Color fundus photograph, 2352x1568px, 45-degree field of view.
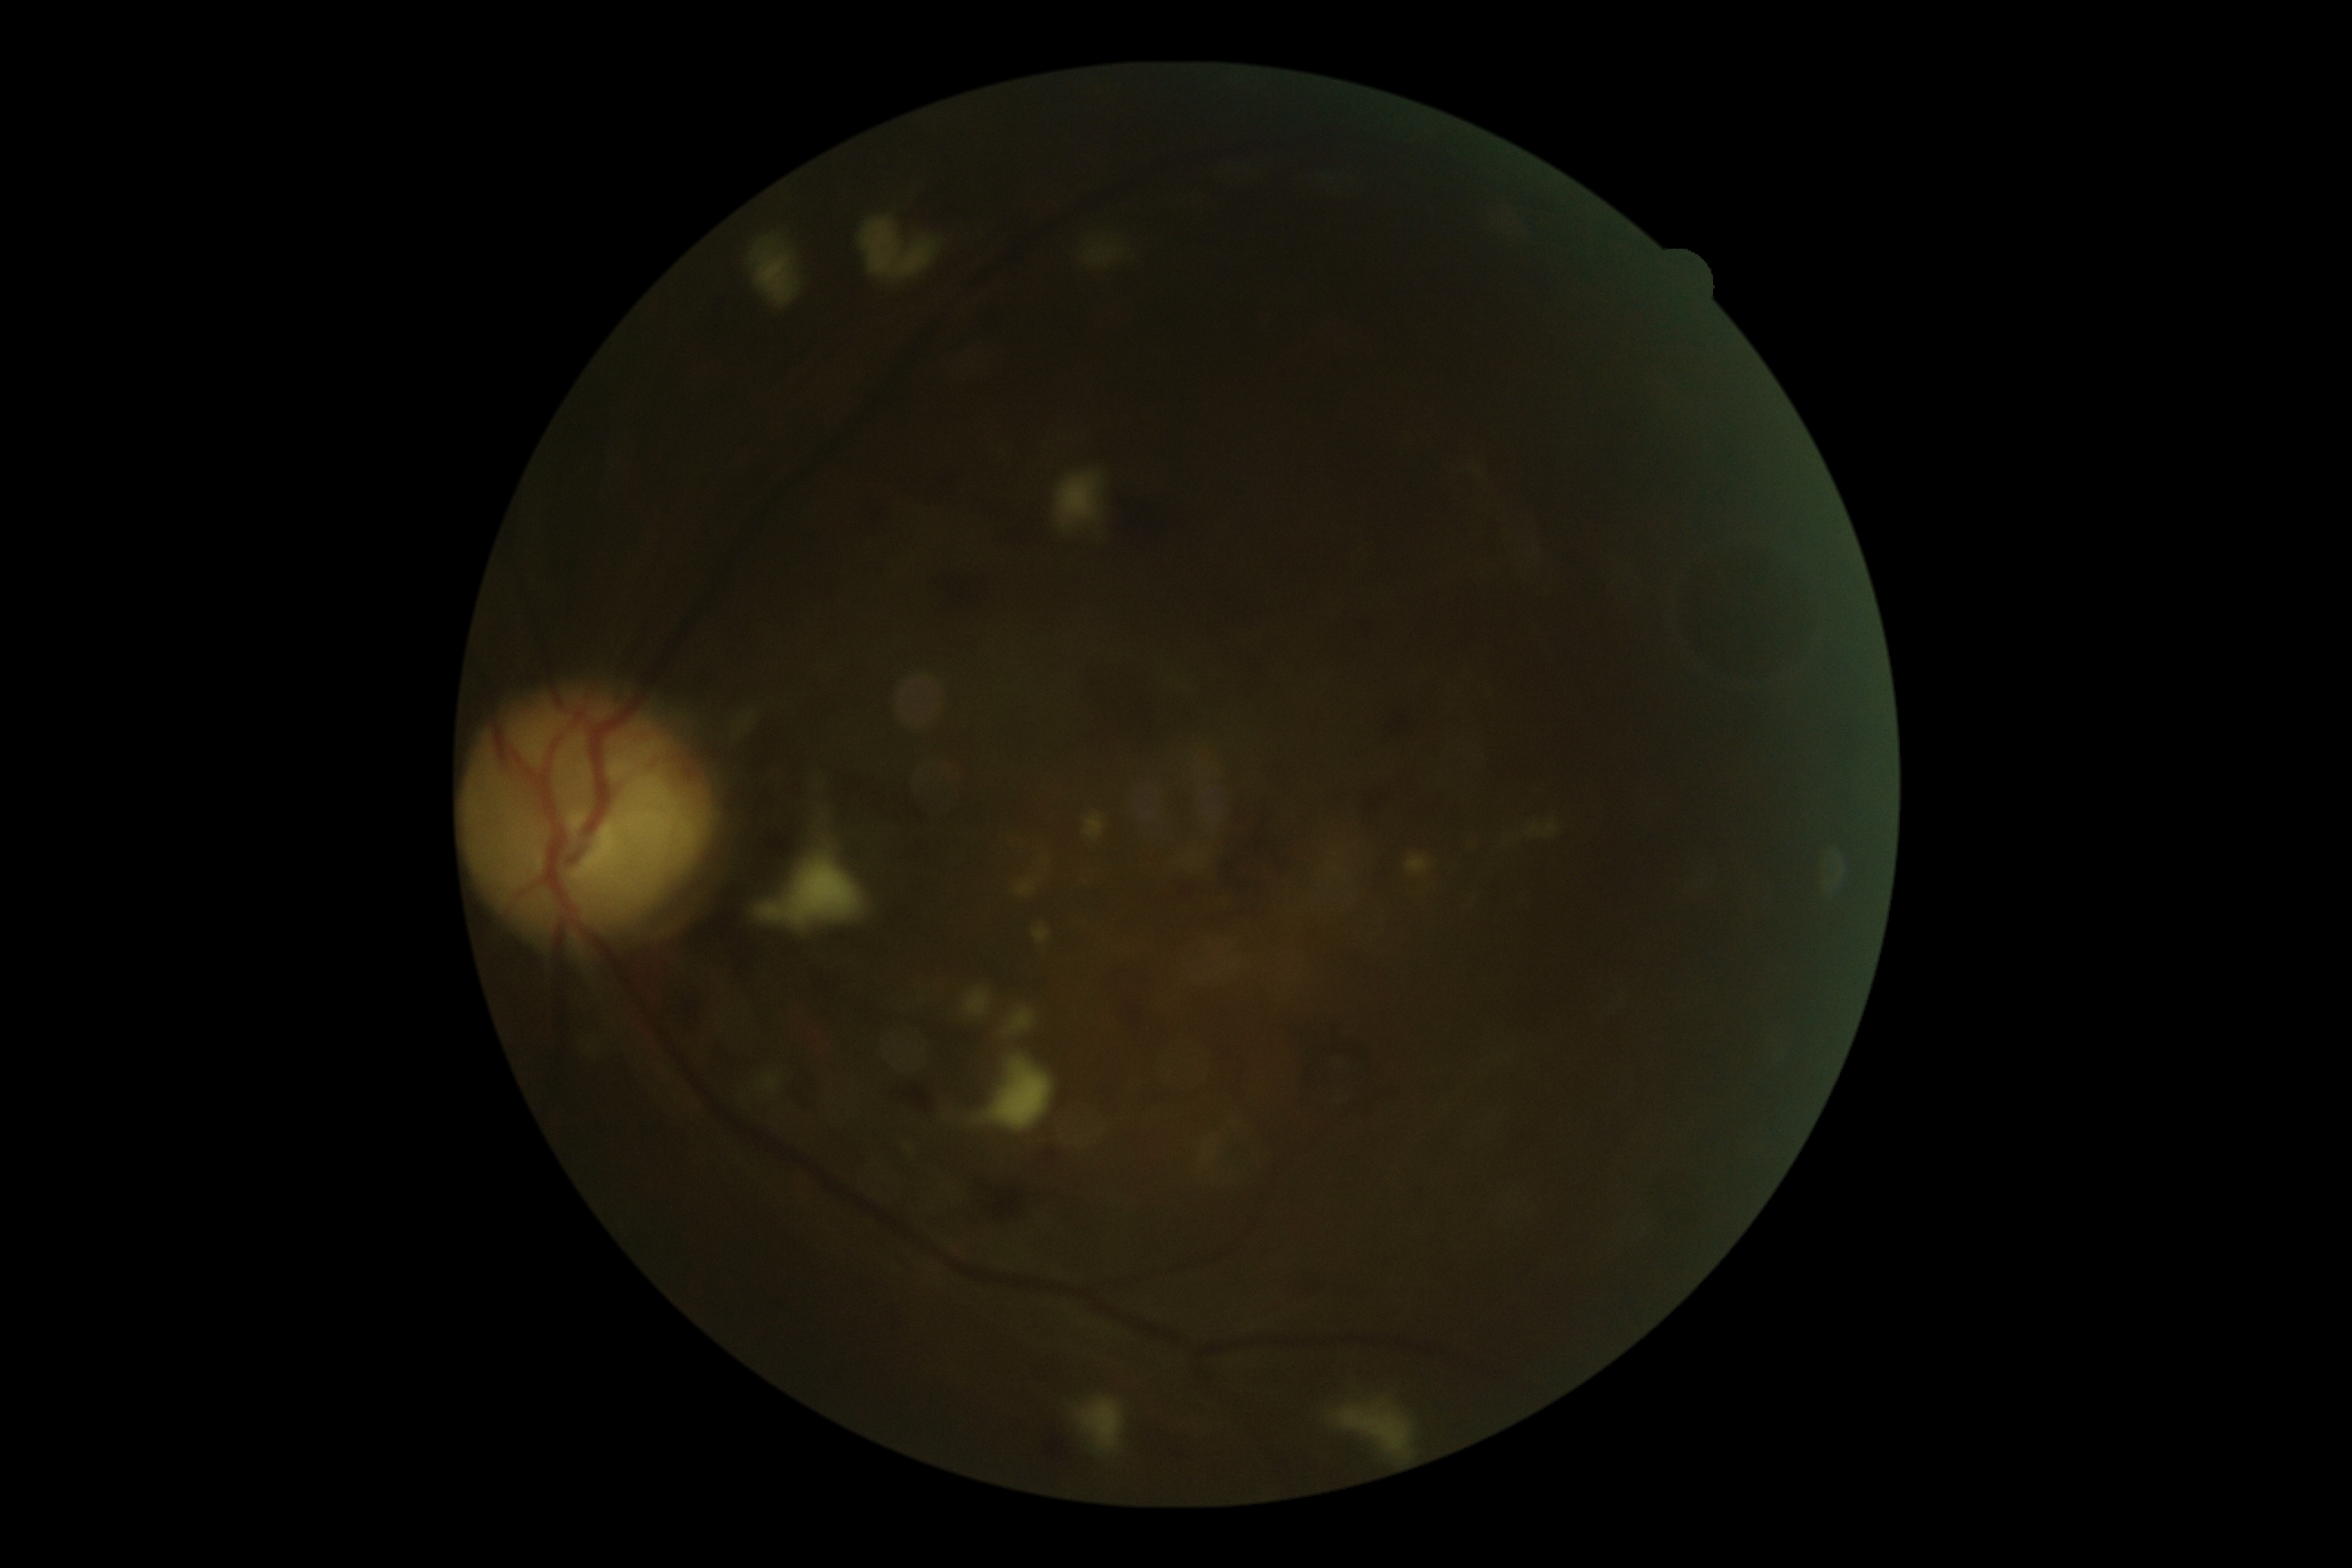

The retinopathy is classified as non-proliferative diabetic retinopathy. DR: grade 3.